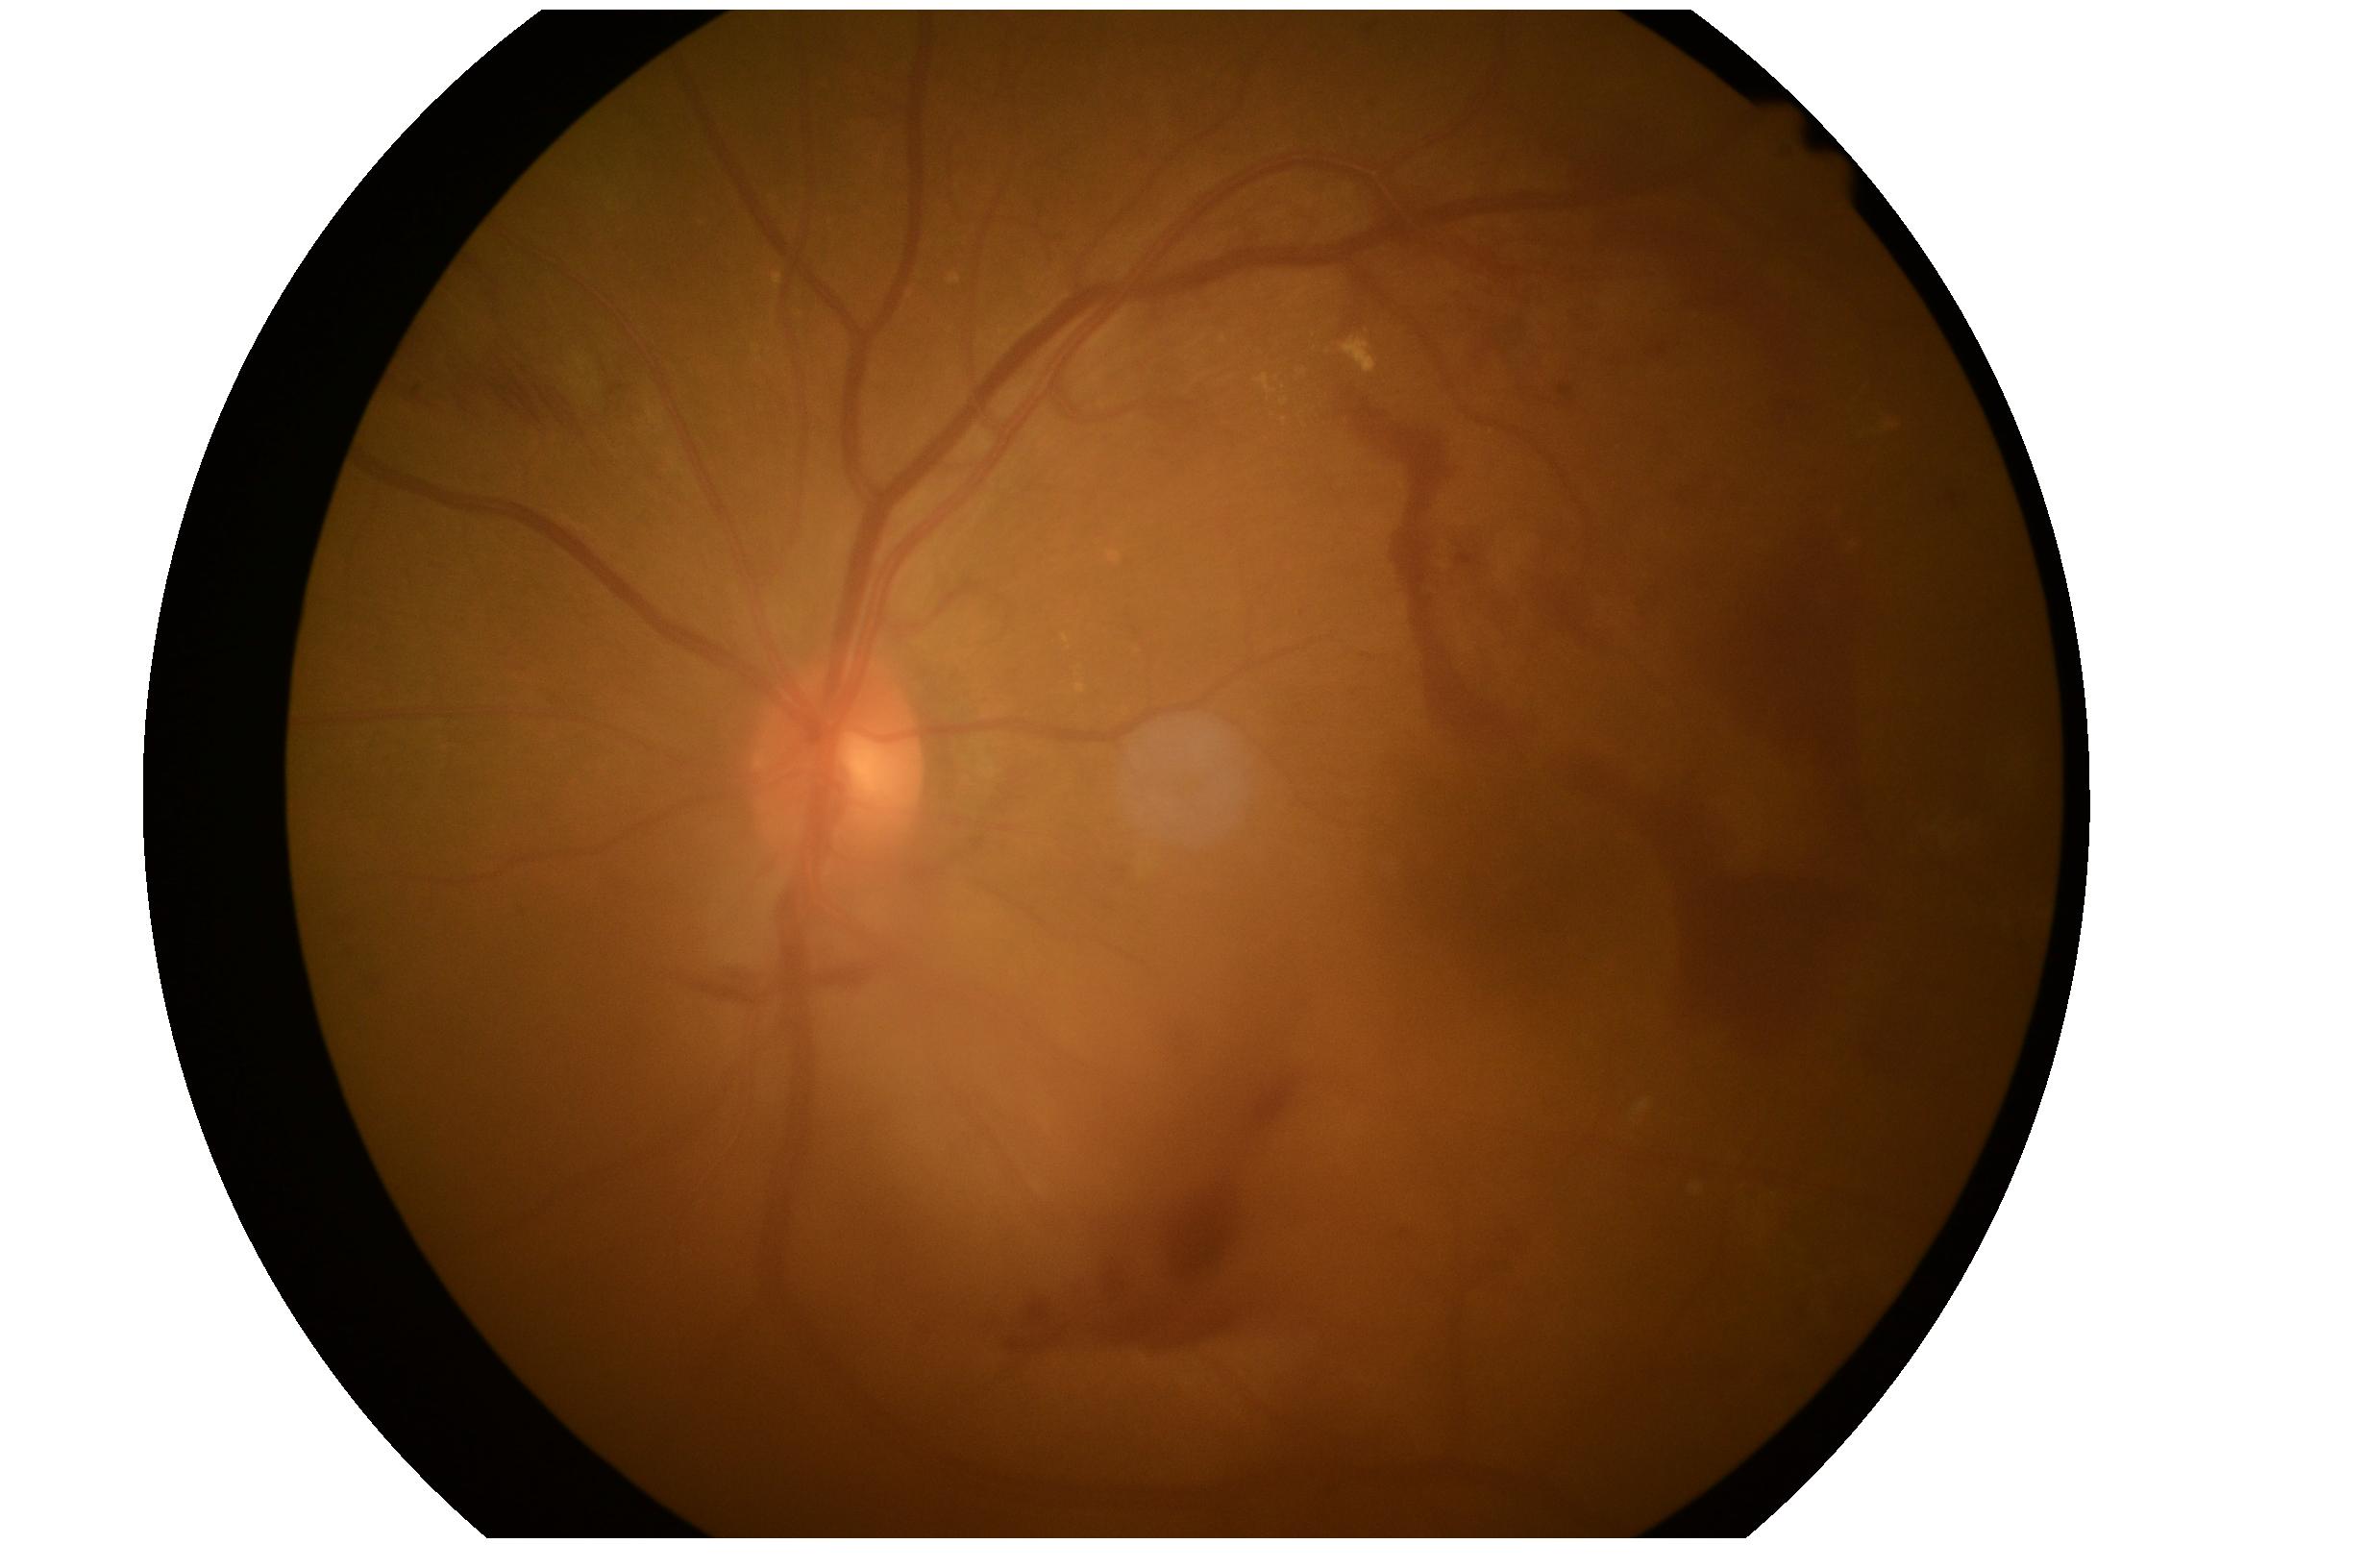
Retinopathy grade is 4 (PDR). DR class: proliferative diabetic retinopathy.